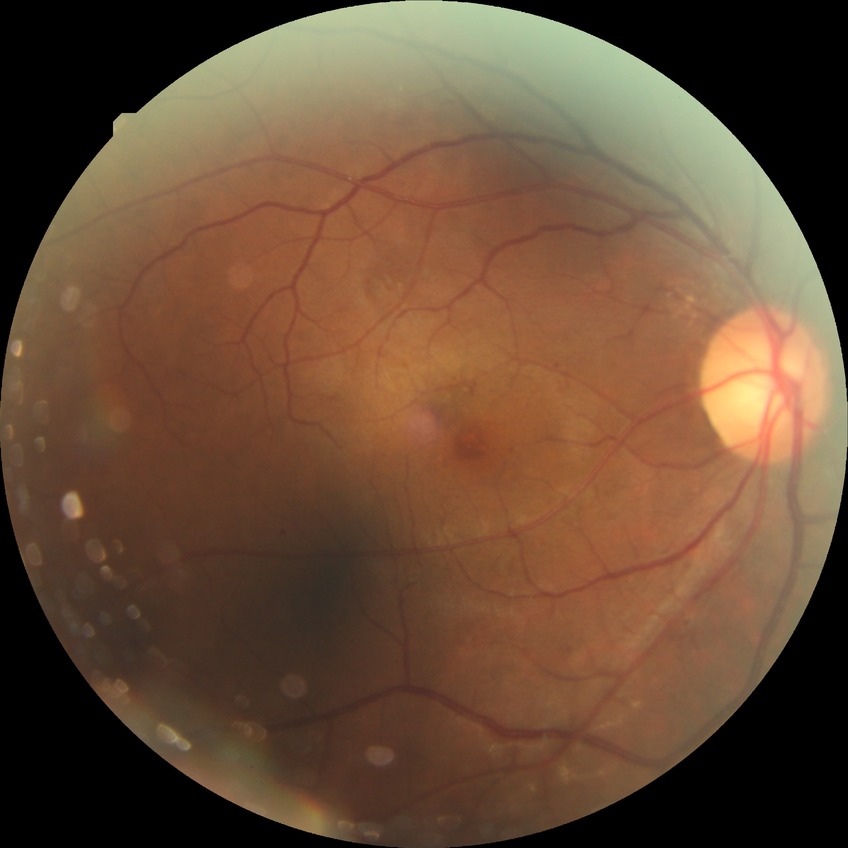 Davis grading: pre-proliferative diabetic retinopathy.